Color fundus photograph centered on the optic disc — 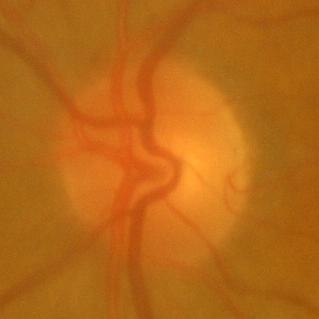

Showing no glaucomatous changes.